CFP.
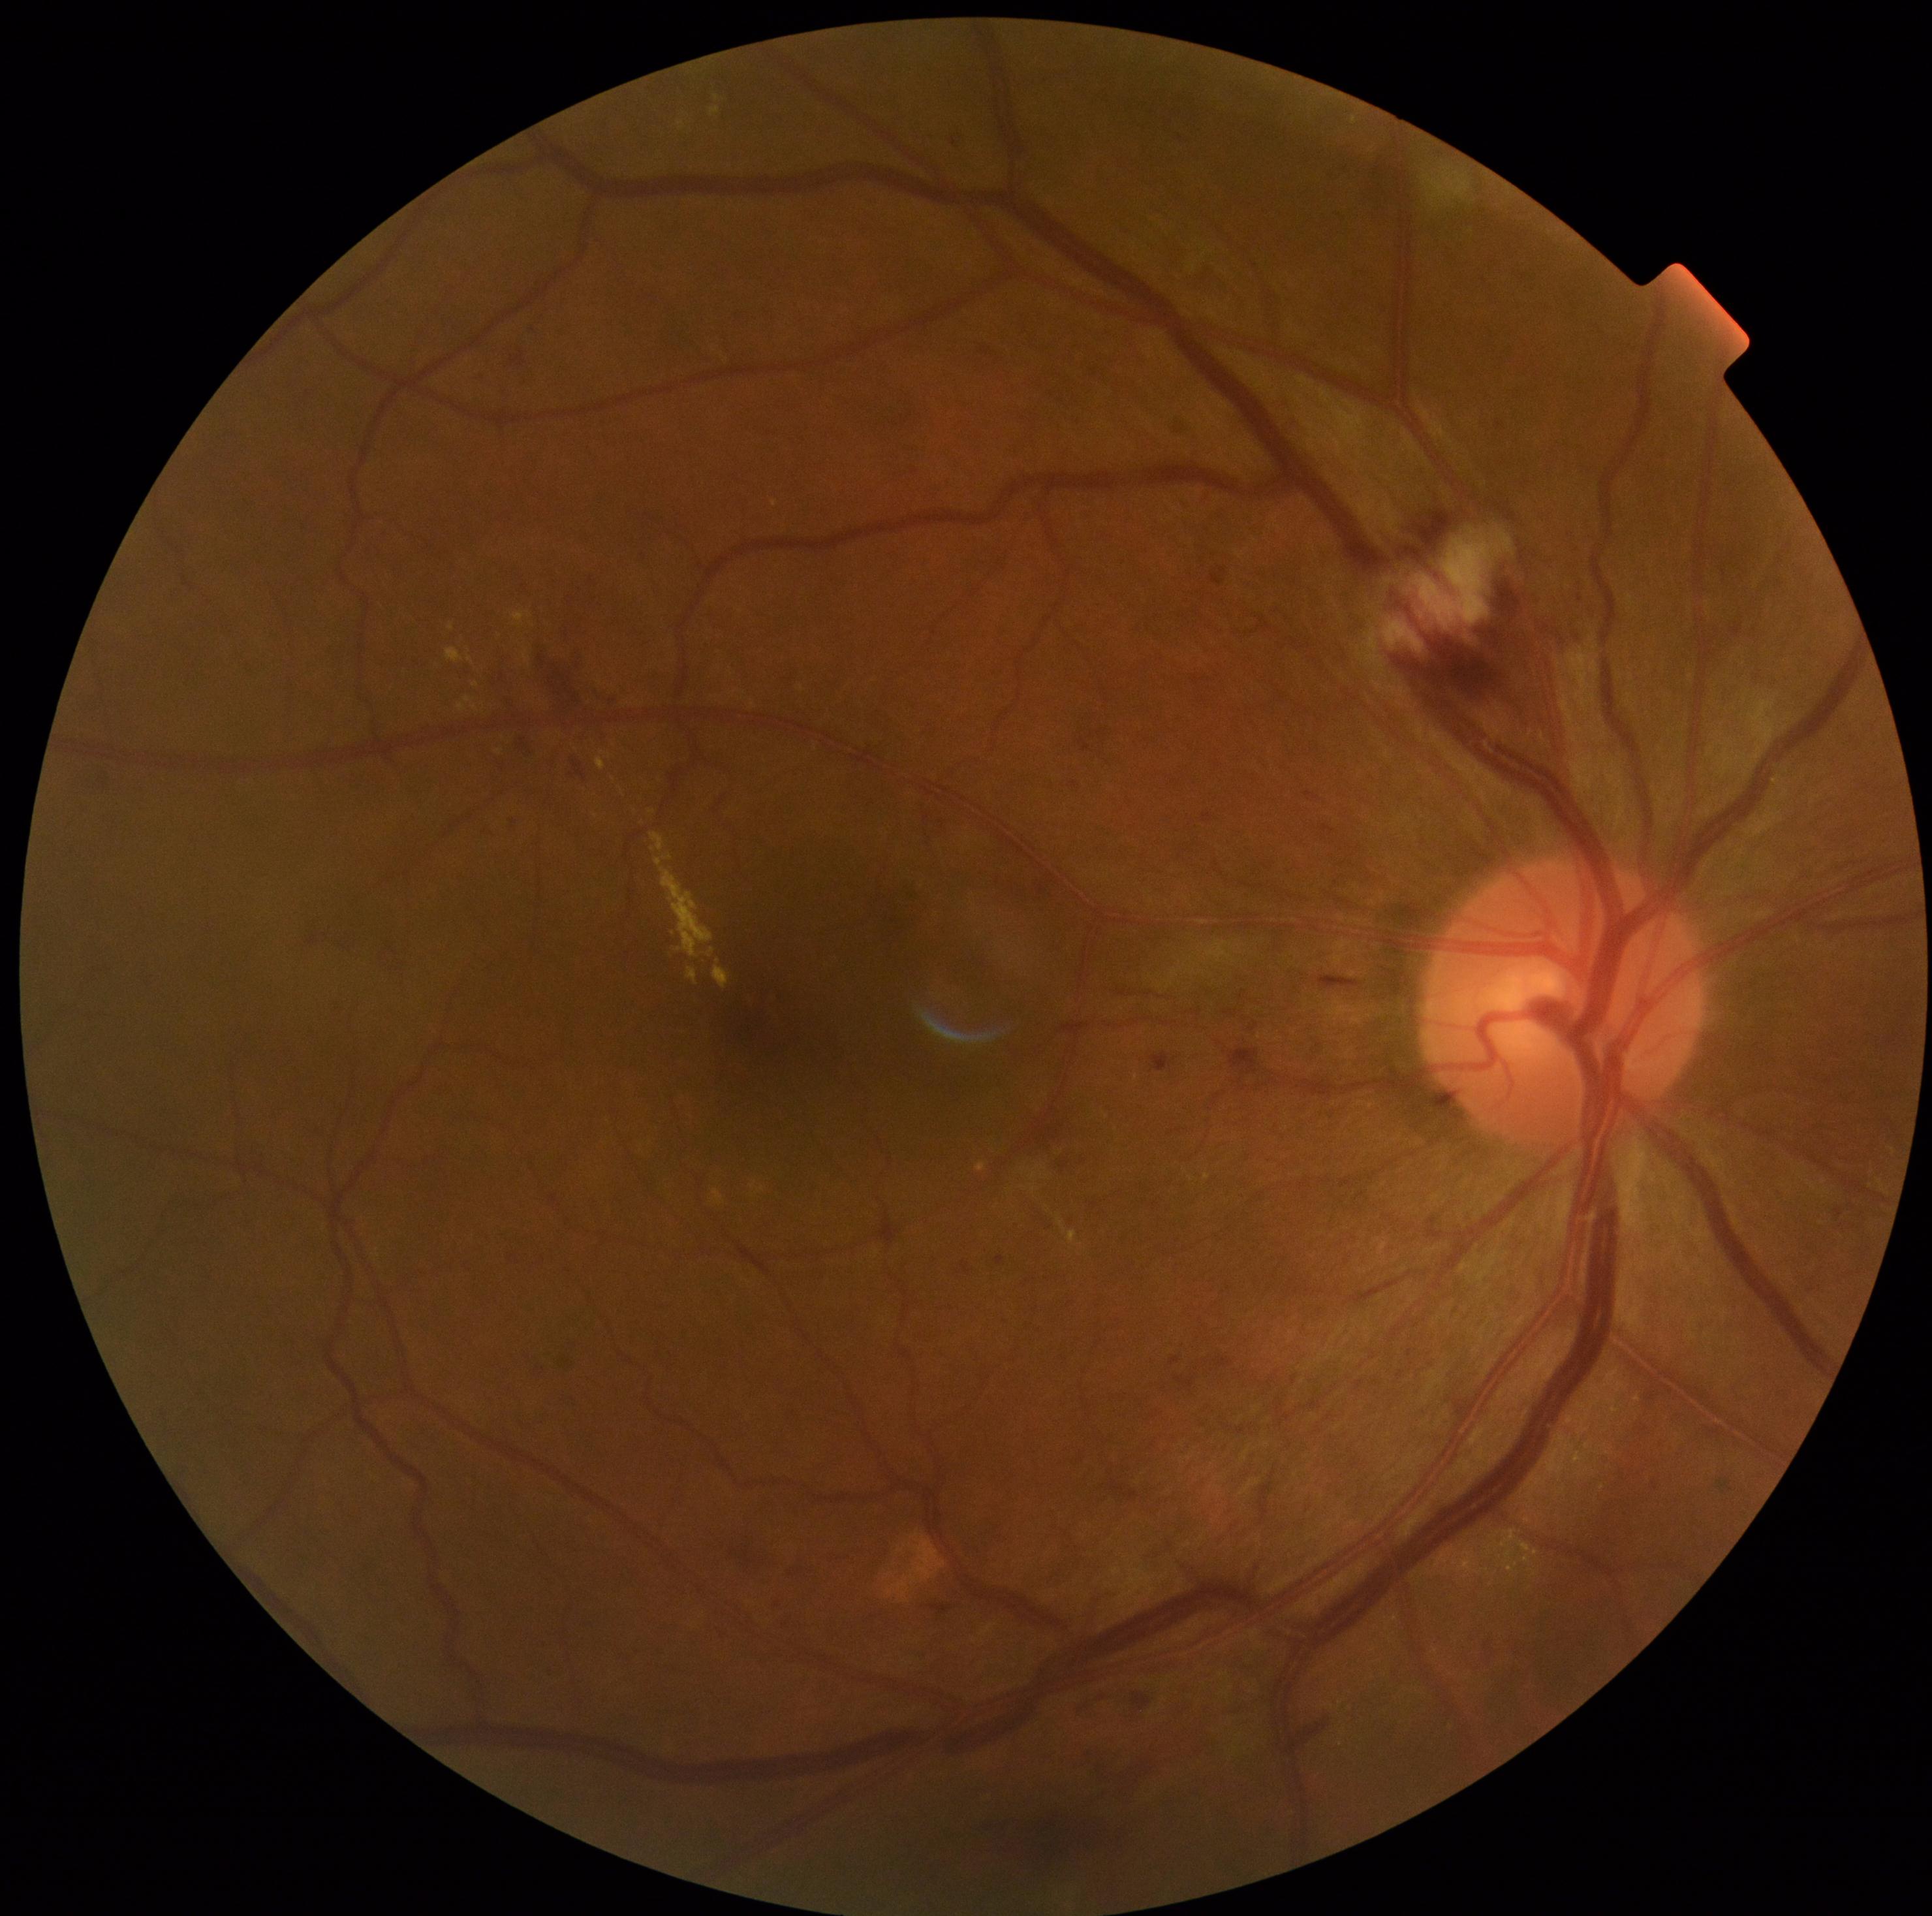 diabetic retinopathy (DR)@moderate NPDR (grade 2).